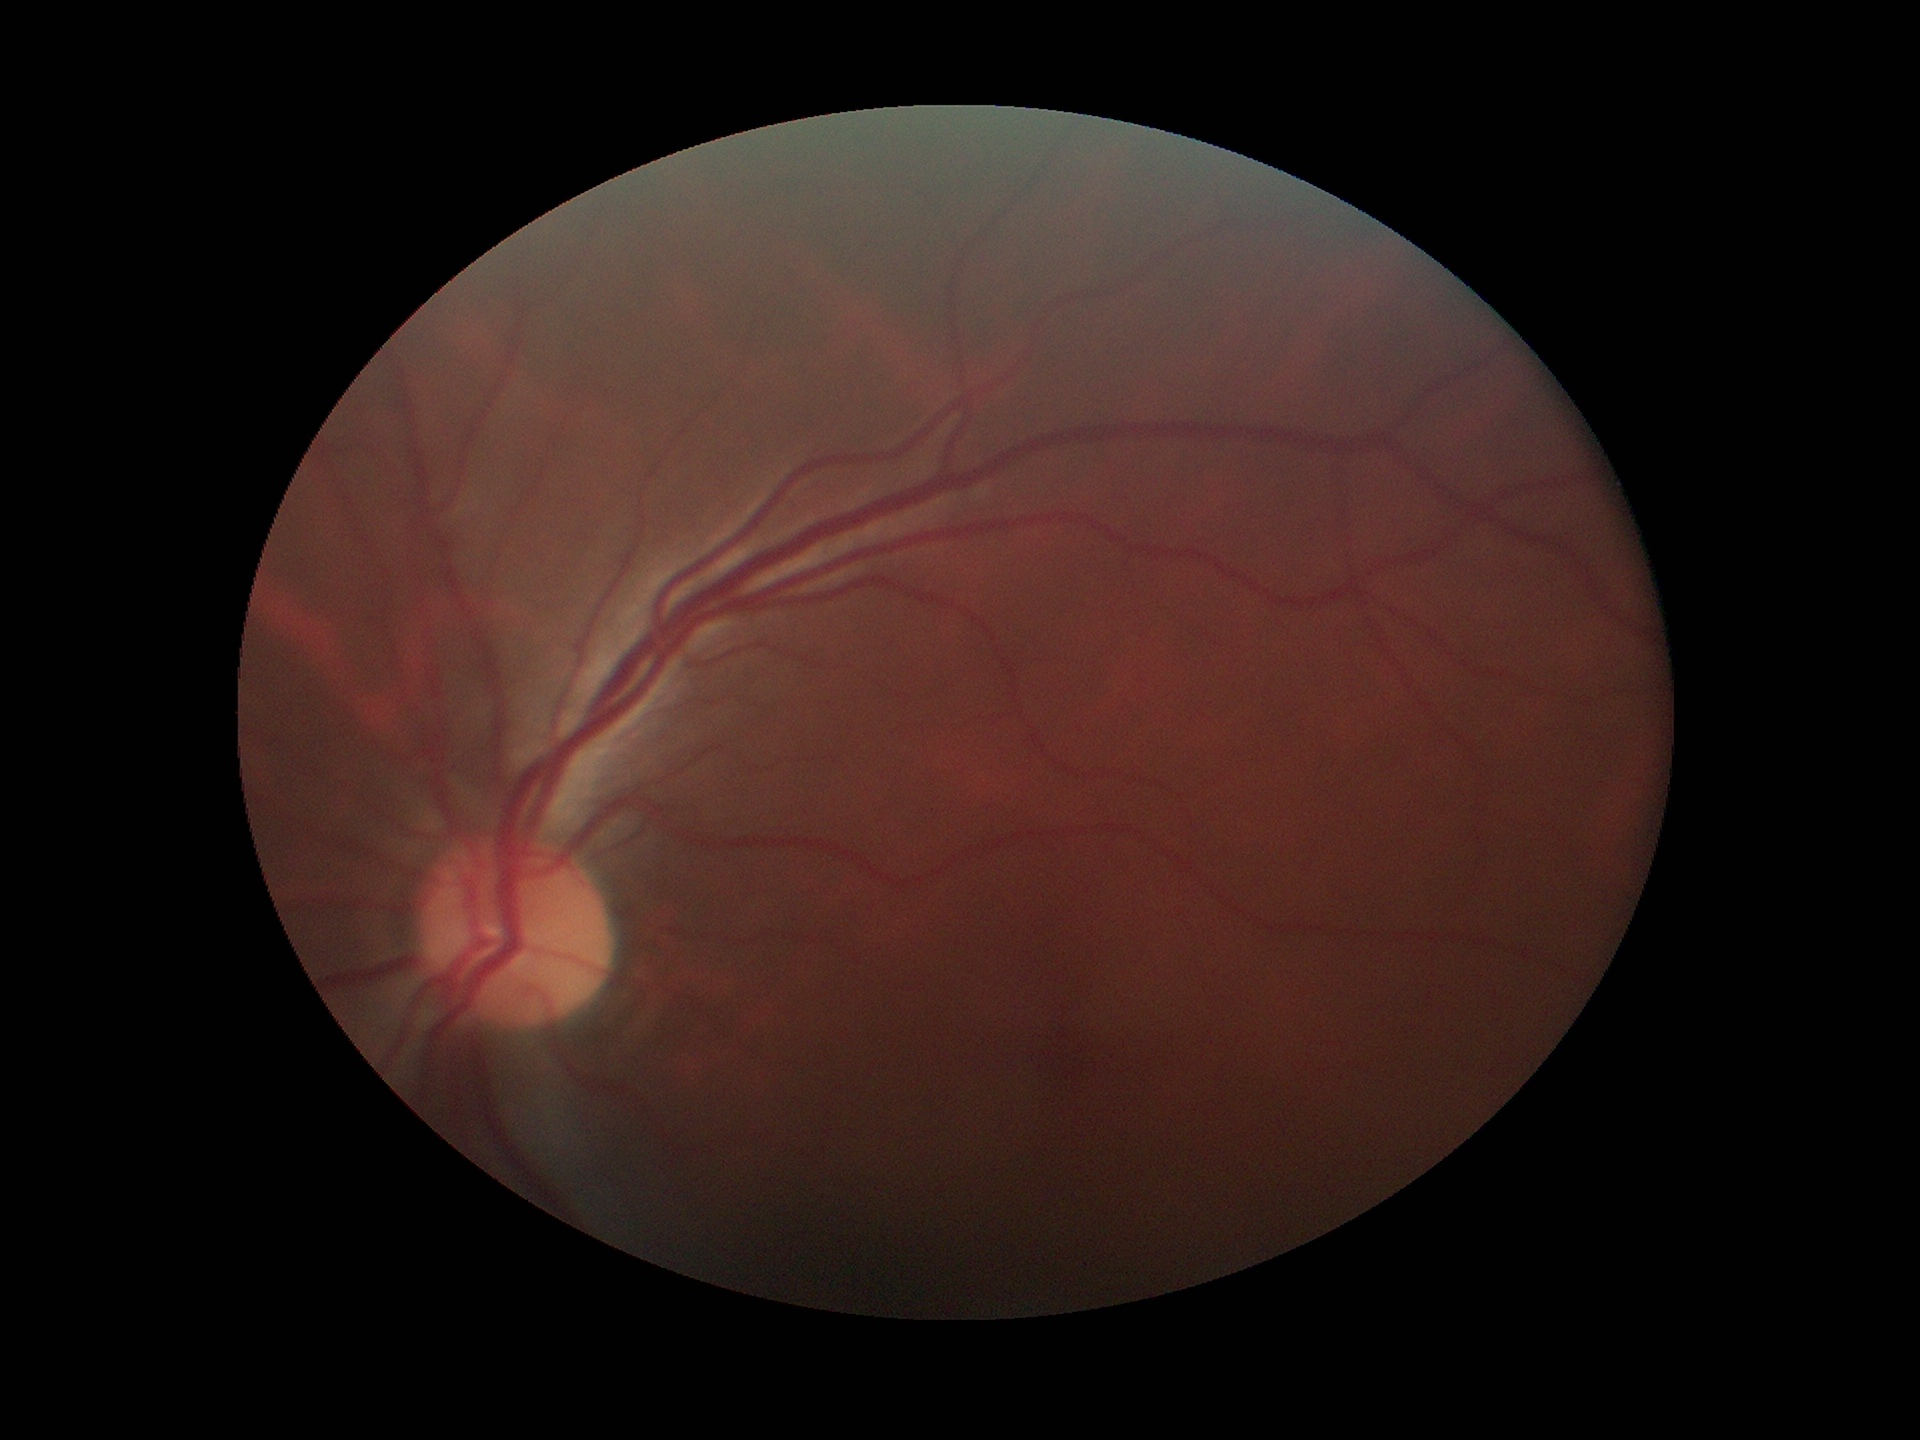

Glaucoma screening impression: not suspect.
Vertical CDR is 0.44.
Horizontal CDR is 0.48.